Infant wide-field retinal image. Camera: Natus RetCam Envision (130° FOV) — 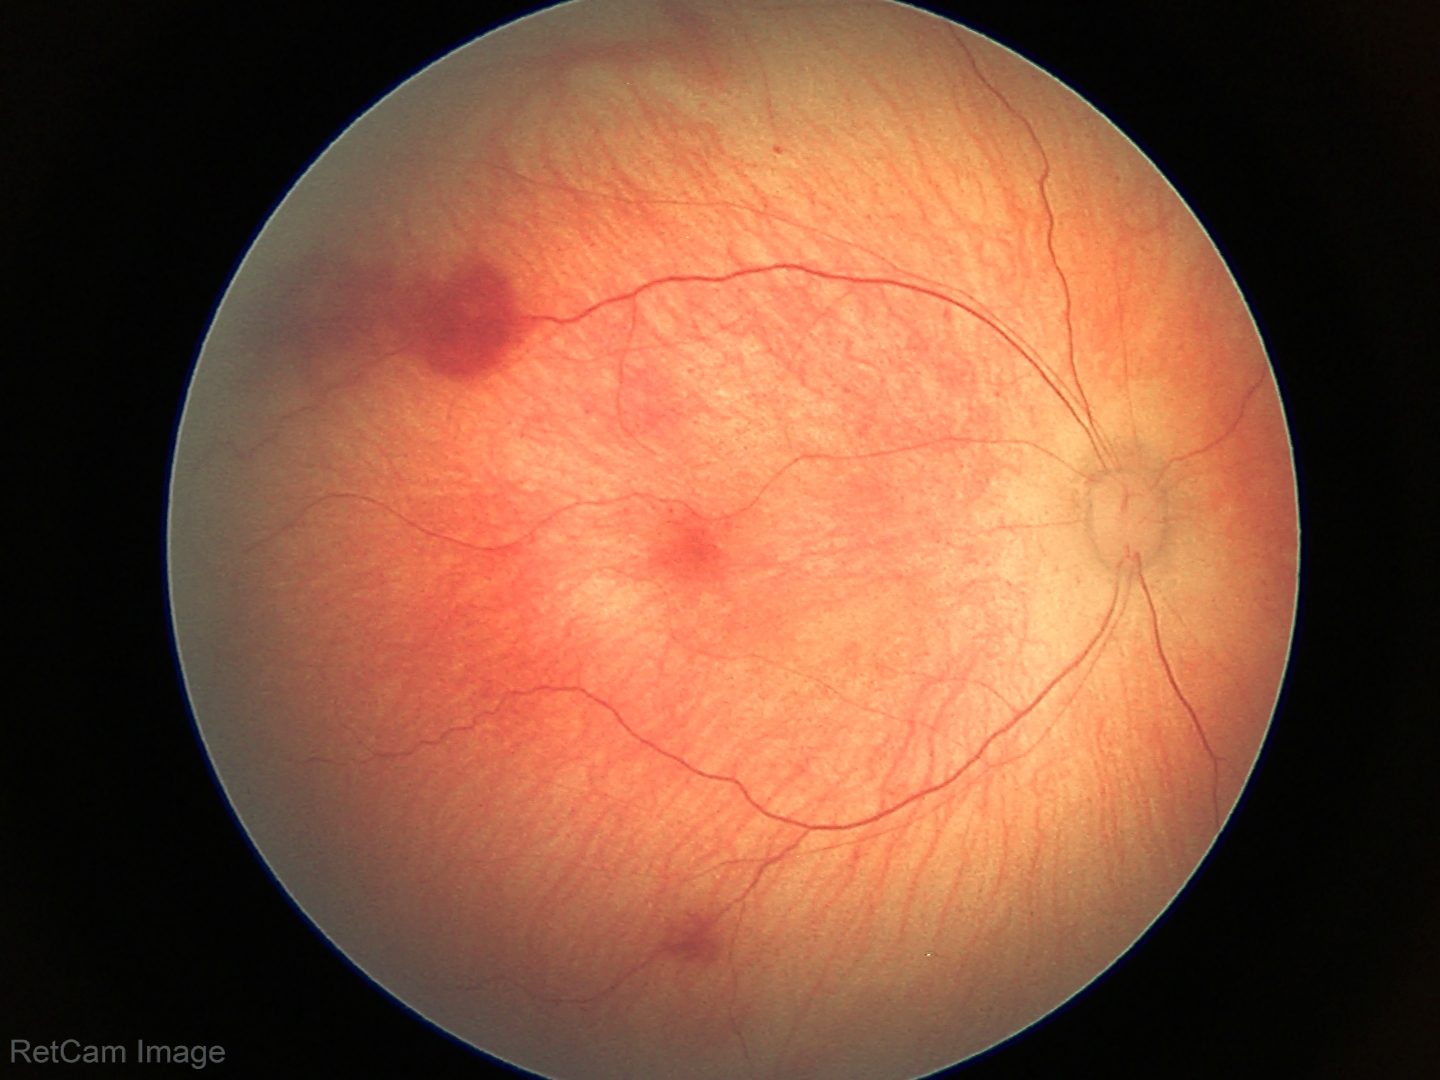
Impression = retinal hemorrhages.